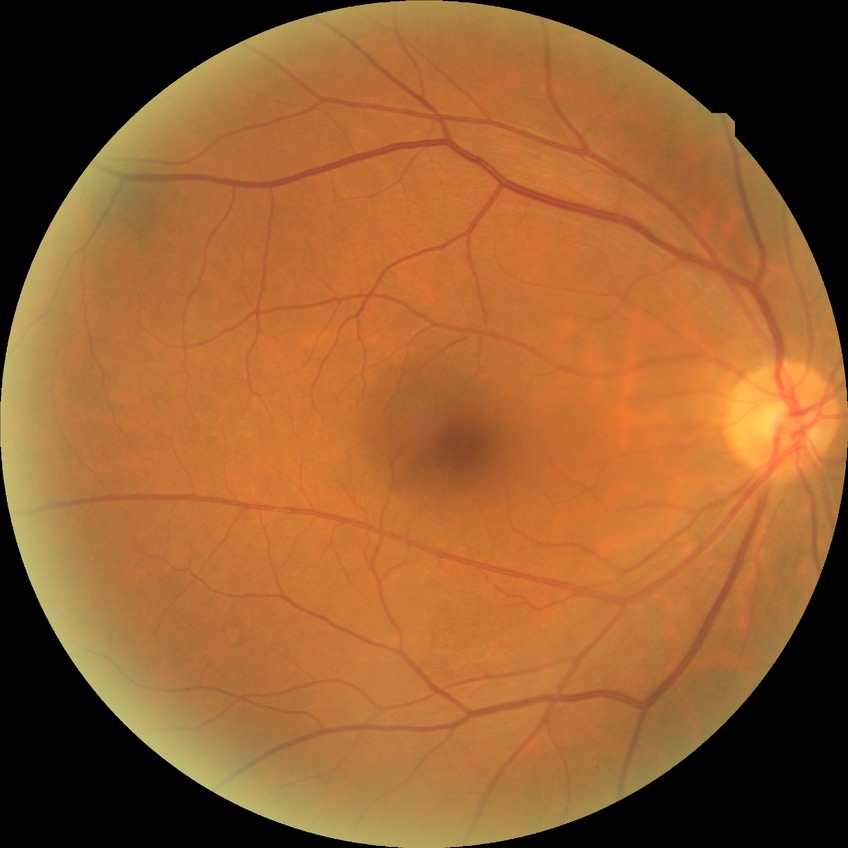

diabetic retinopathy (DR)@NDR (no diabetic retinopathy).